Pediatric wide-field fundus photograph; 130° field of view (Clarity RetCam 3) — 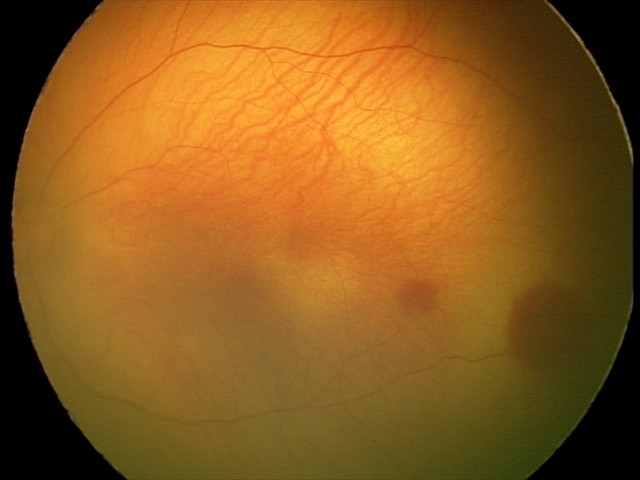

Series diagnosed as retinal hemorrhages.